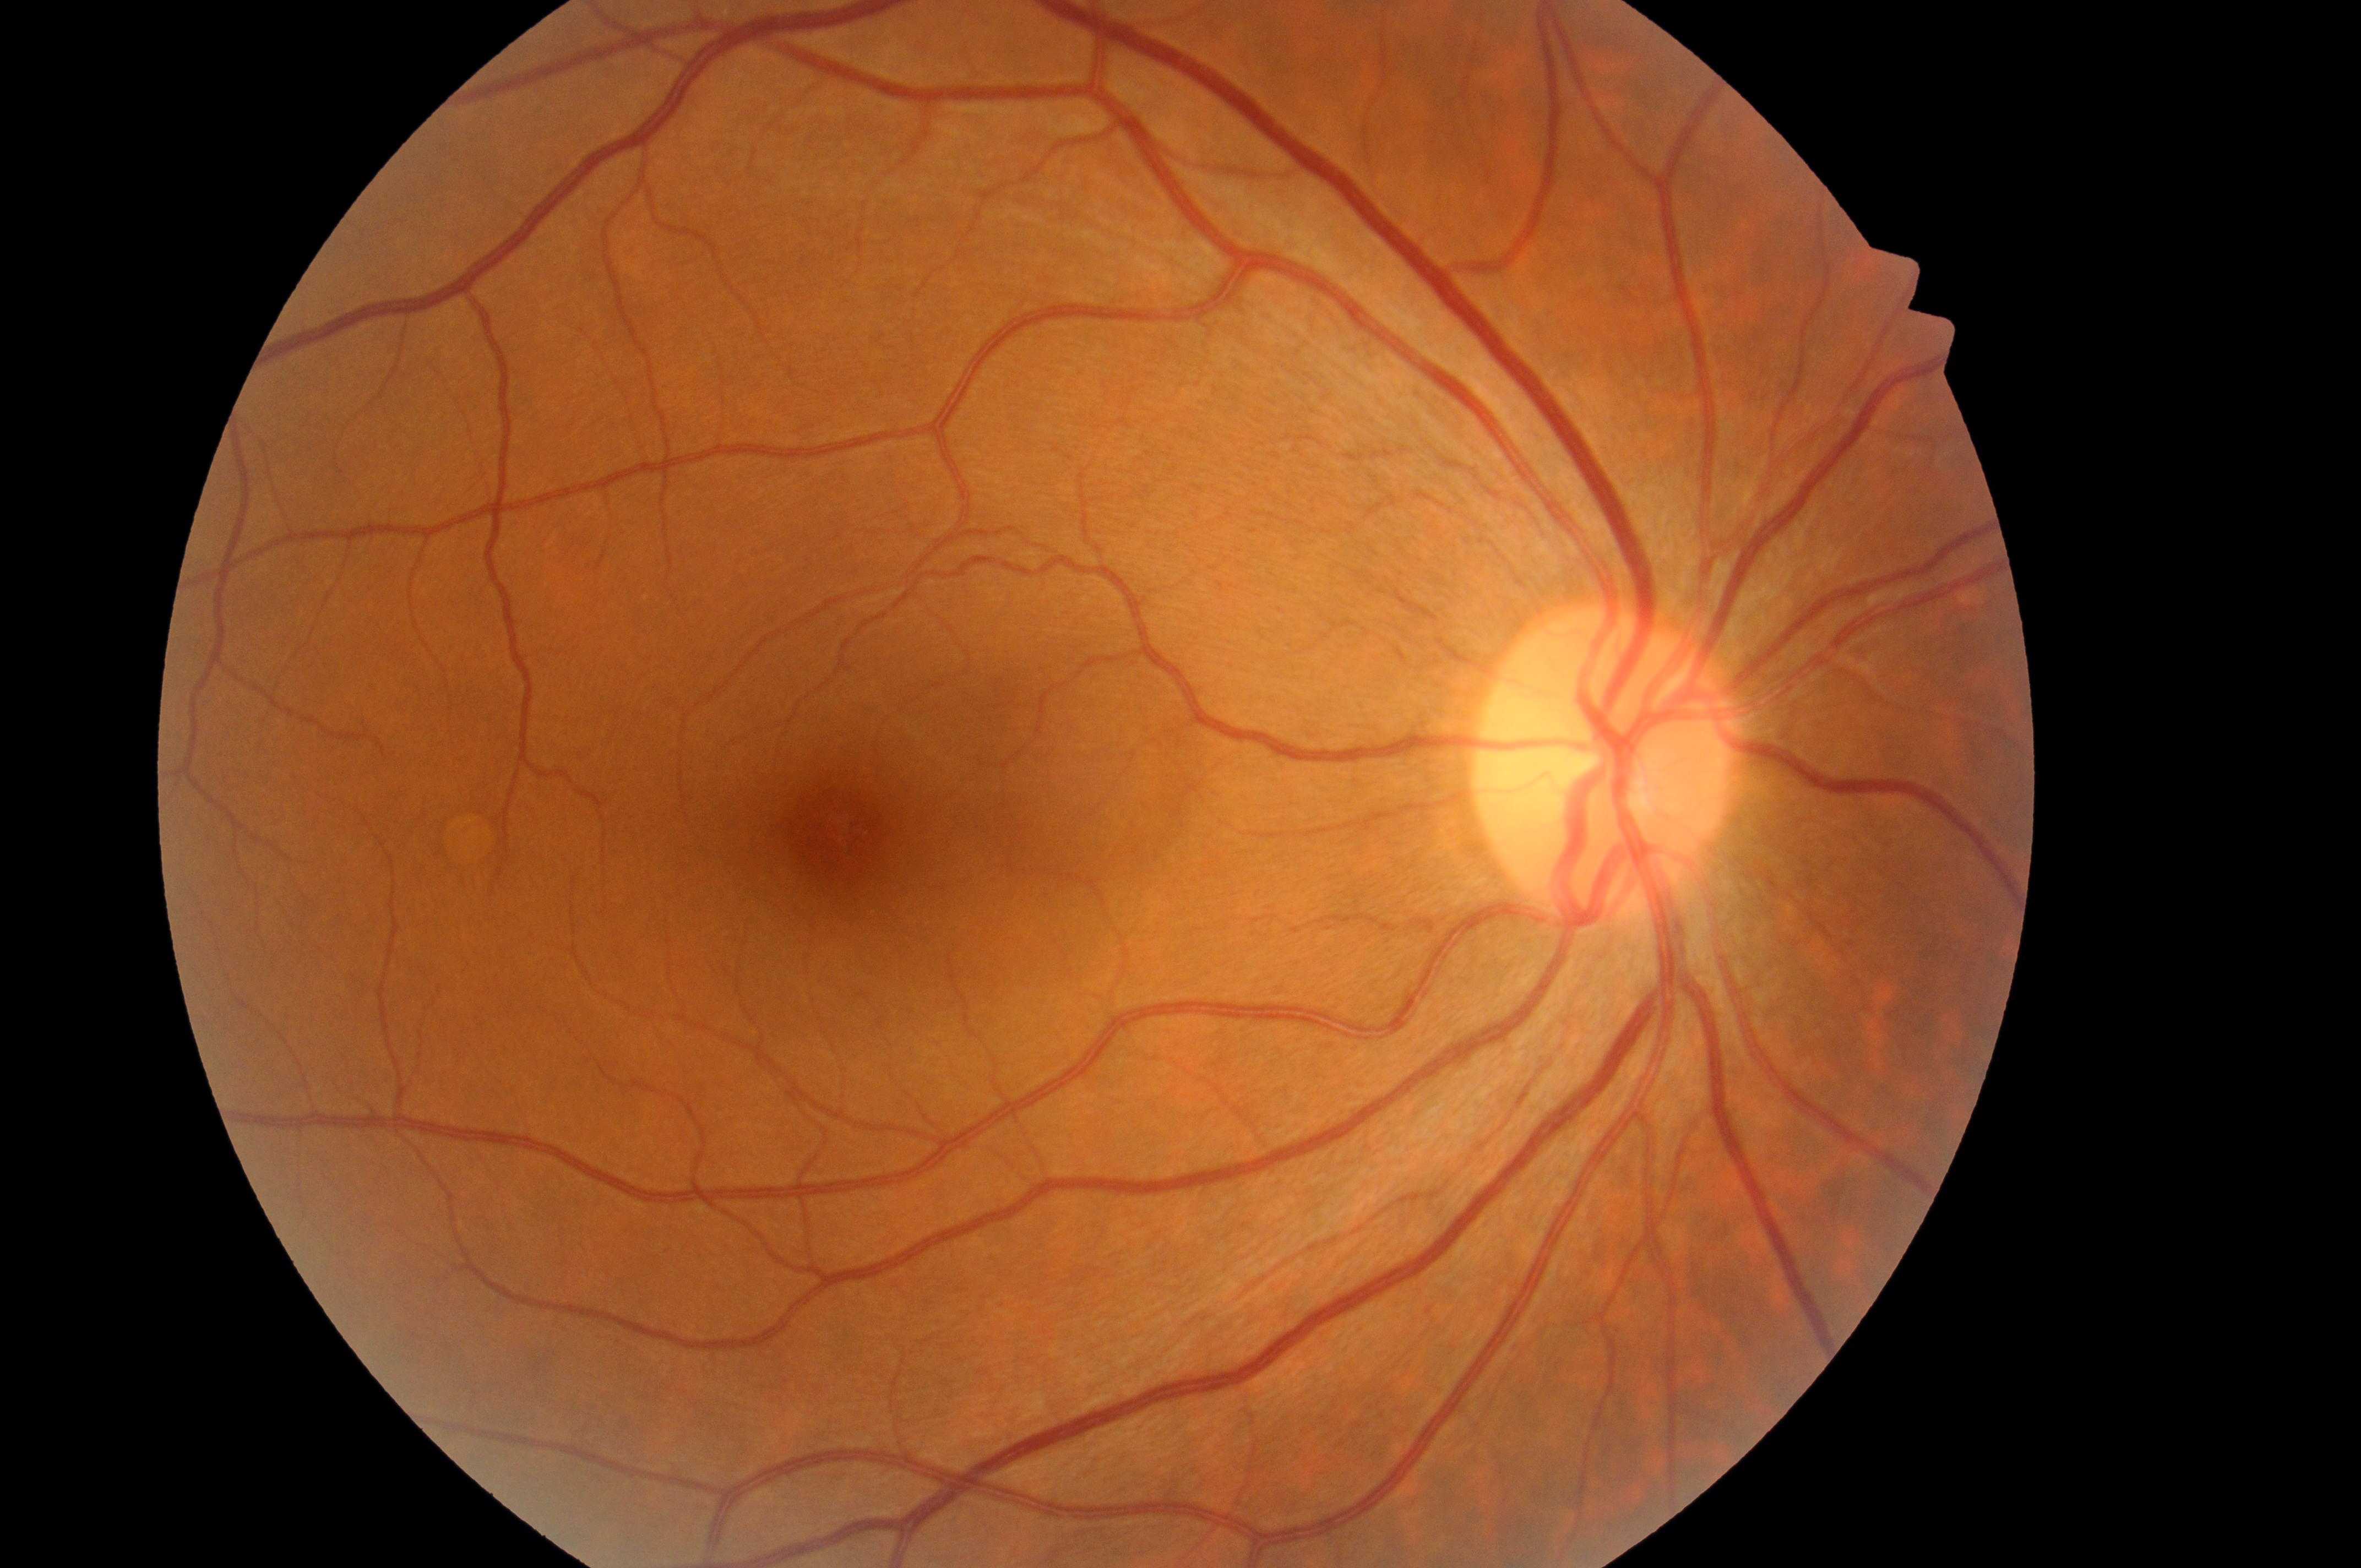 | feature | annotation |
|---|---|
| fovea center | (x=835, y=831) |
| DR grade | 0 |
| optic nerve head | (x=1595, y=771) |
| laterality | right |
| DME risk | grade 0 |